130° field of view (Natus RetCam Envision); infant wide-field fundus photograph
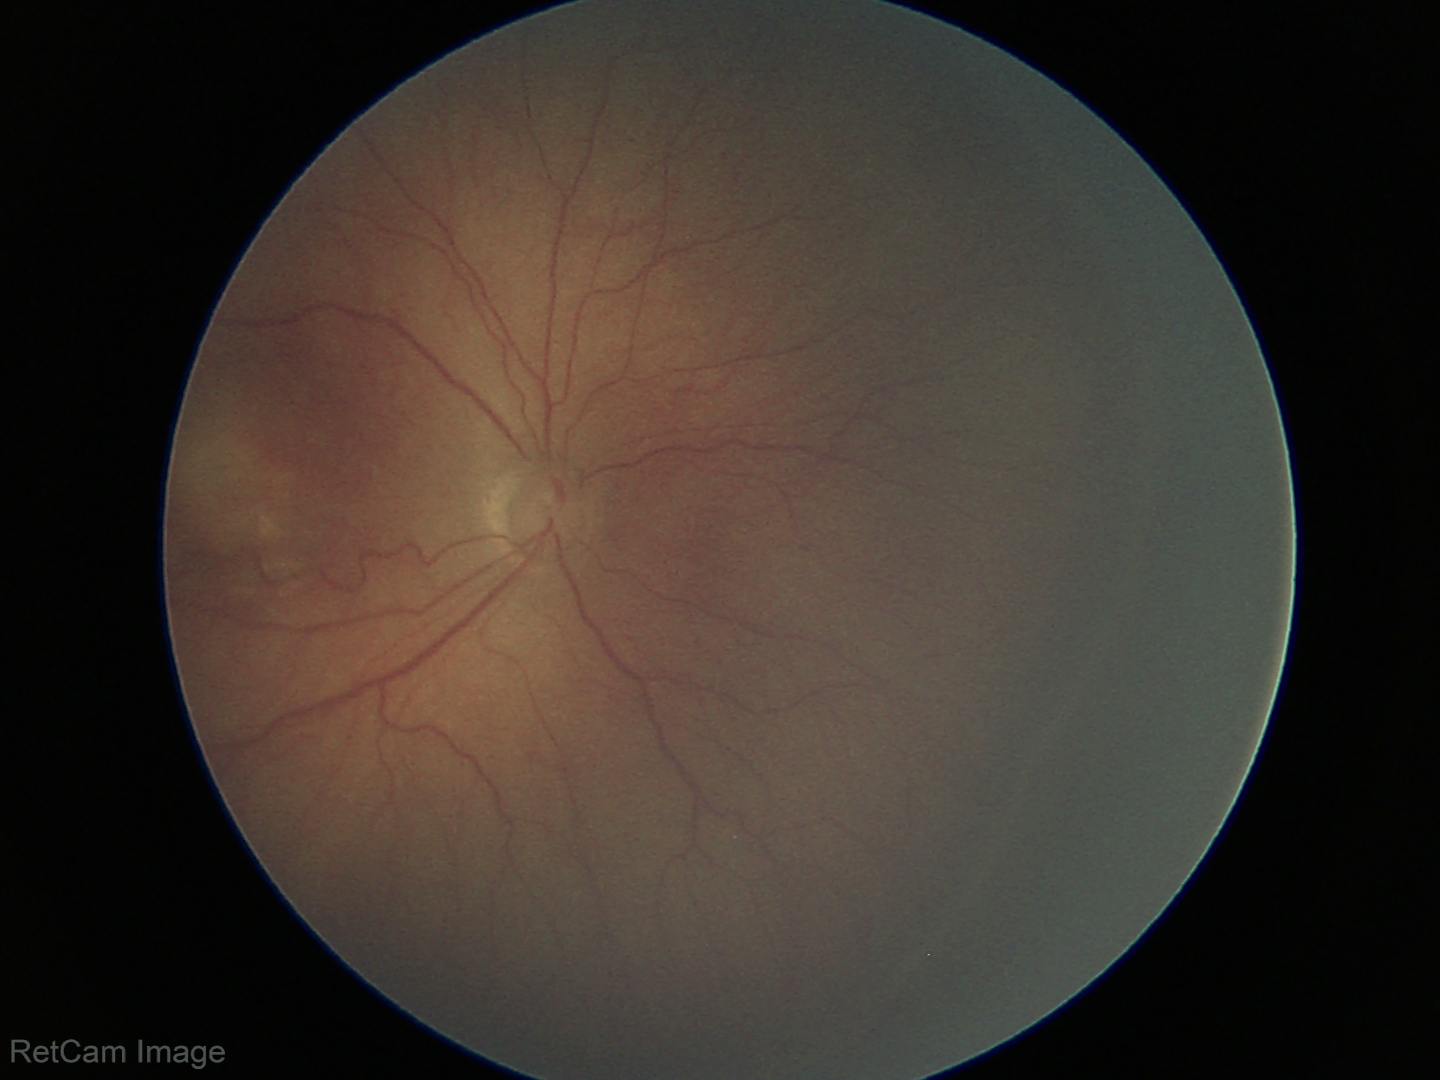

Screening series with retinopathy of prematurity (ROP) stage 3 — ridge with extraretinal fibrovascular proliferation. Plus disease absent.